NIDEK AFC-230 fundus camera · without pupil dilation · CFP · 848 by 848 pixels · 45 degree fundus photograph:
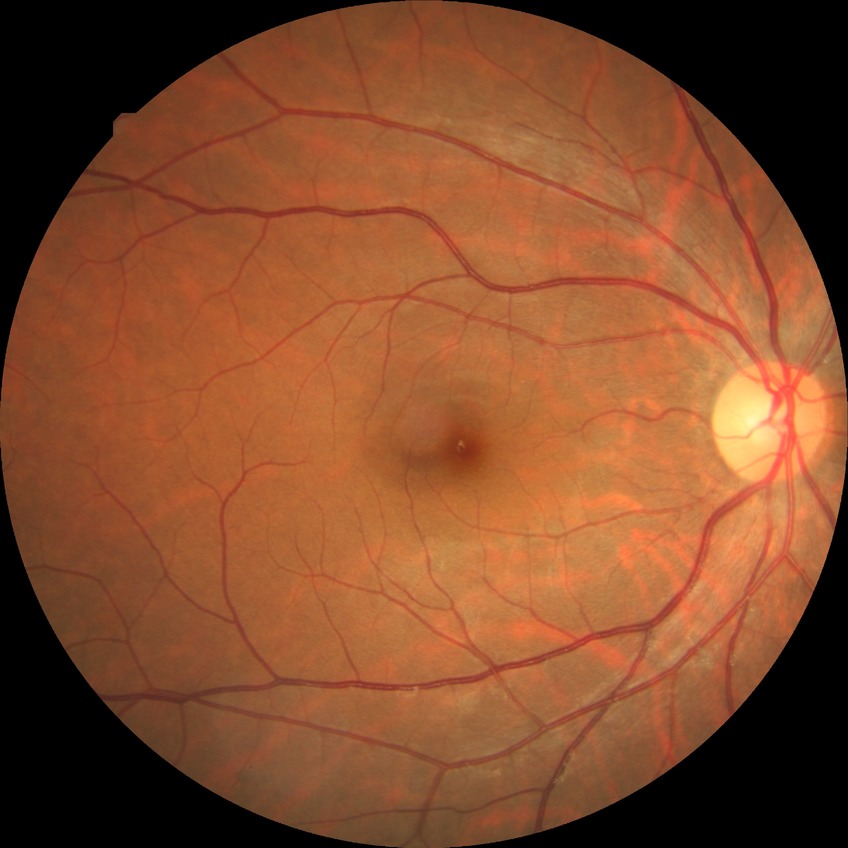

{"davis_grade": "no diabetic retinopathy"}